Color fundus photograph; 848 x 848 pixels; camera: NIDEK AFC-230:
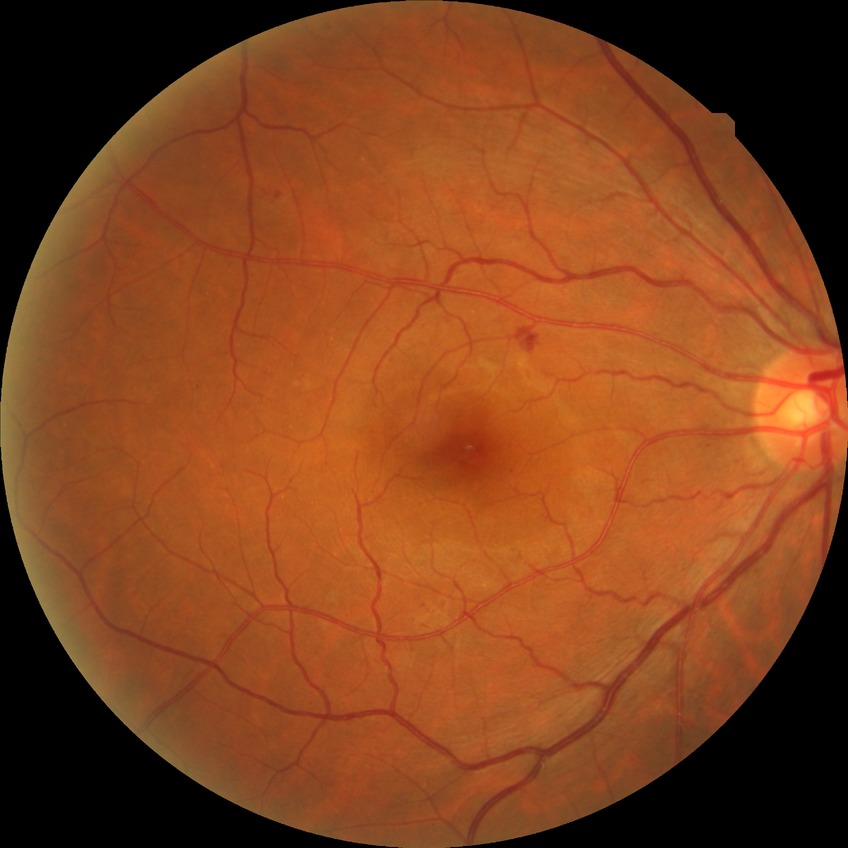
  davis_grade: SDR
  proliferative_class: non-proliferative diabetic retinopathy